45 degree fundus photograph: 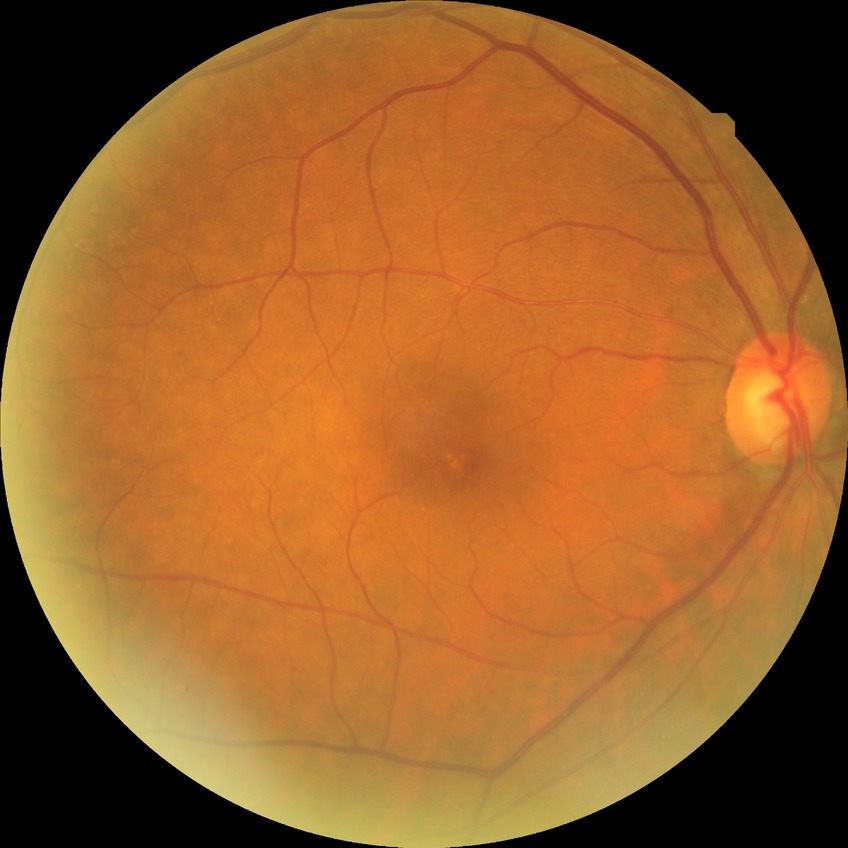
davis_grade: no diabetic retinopathy